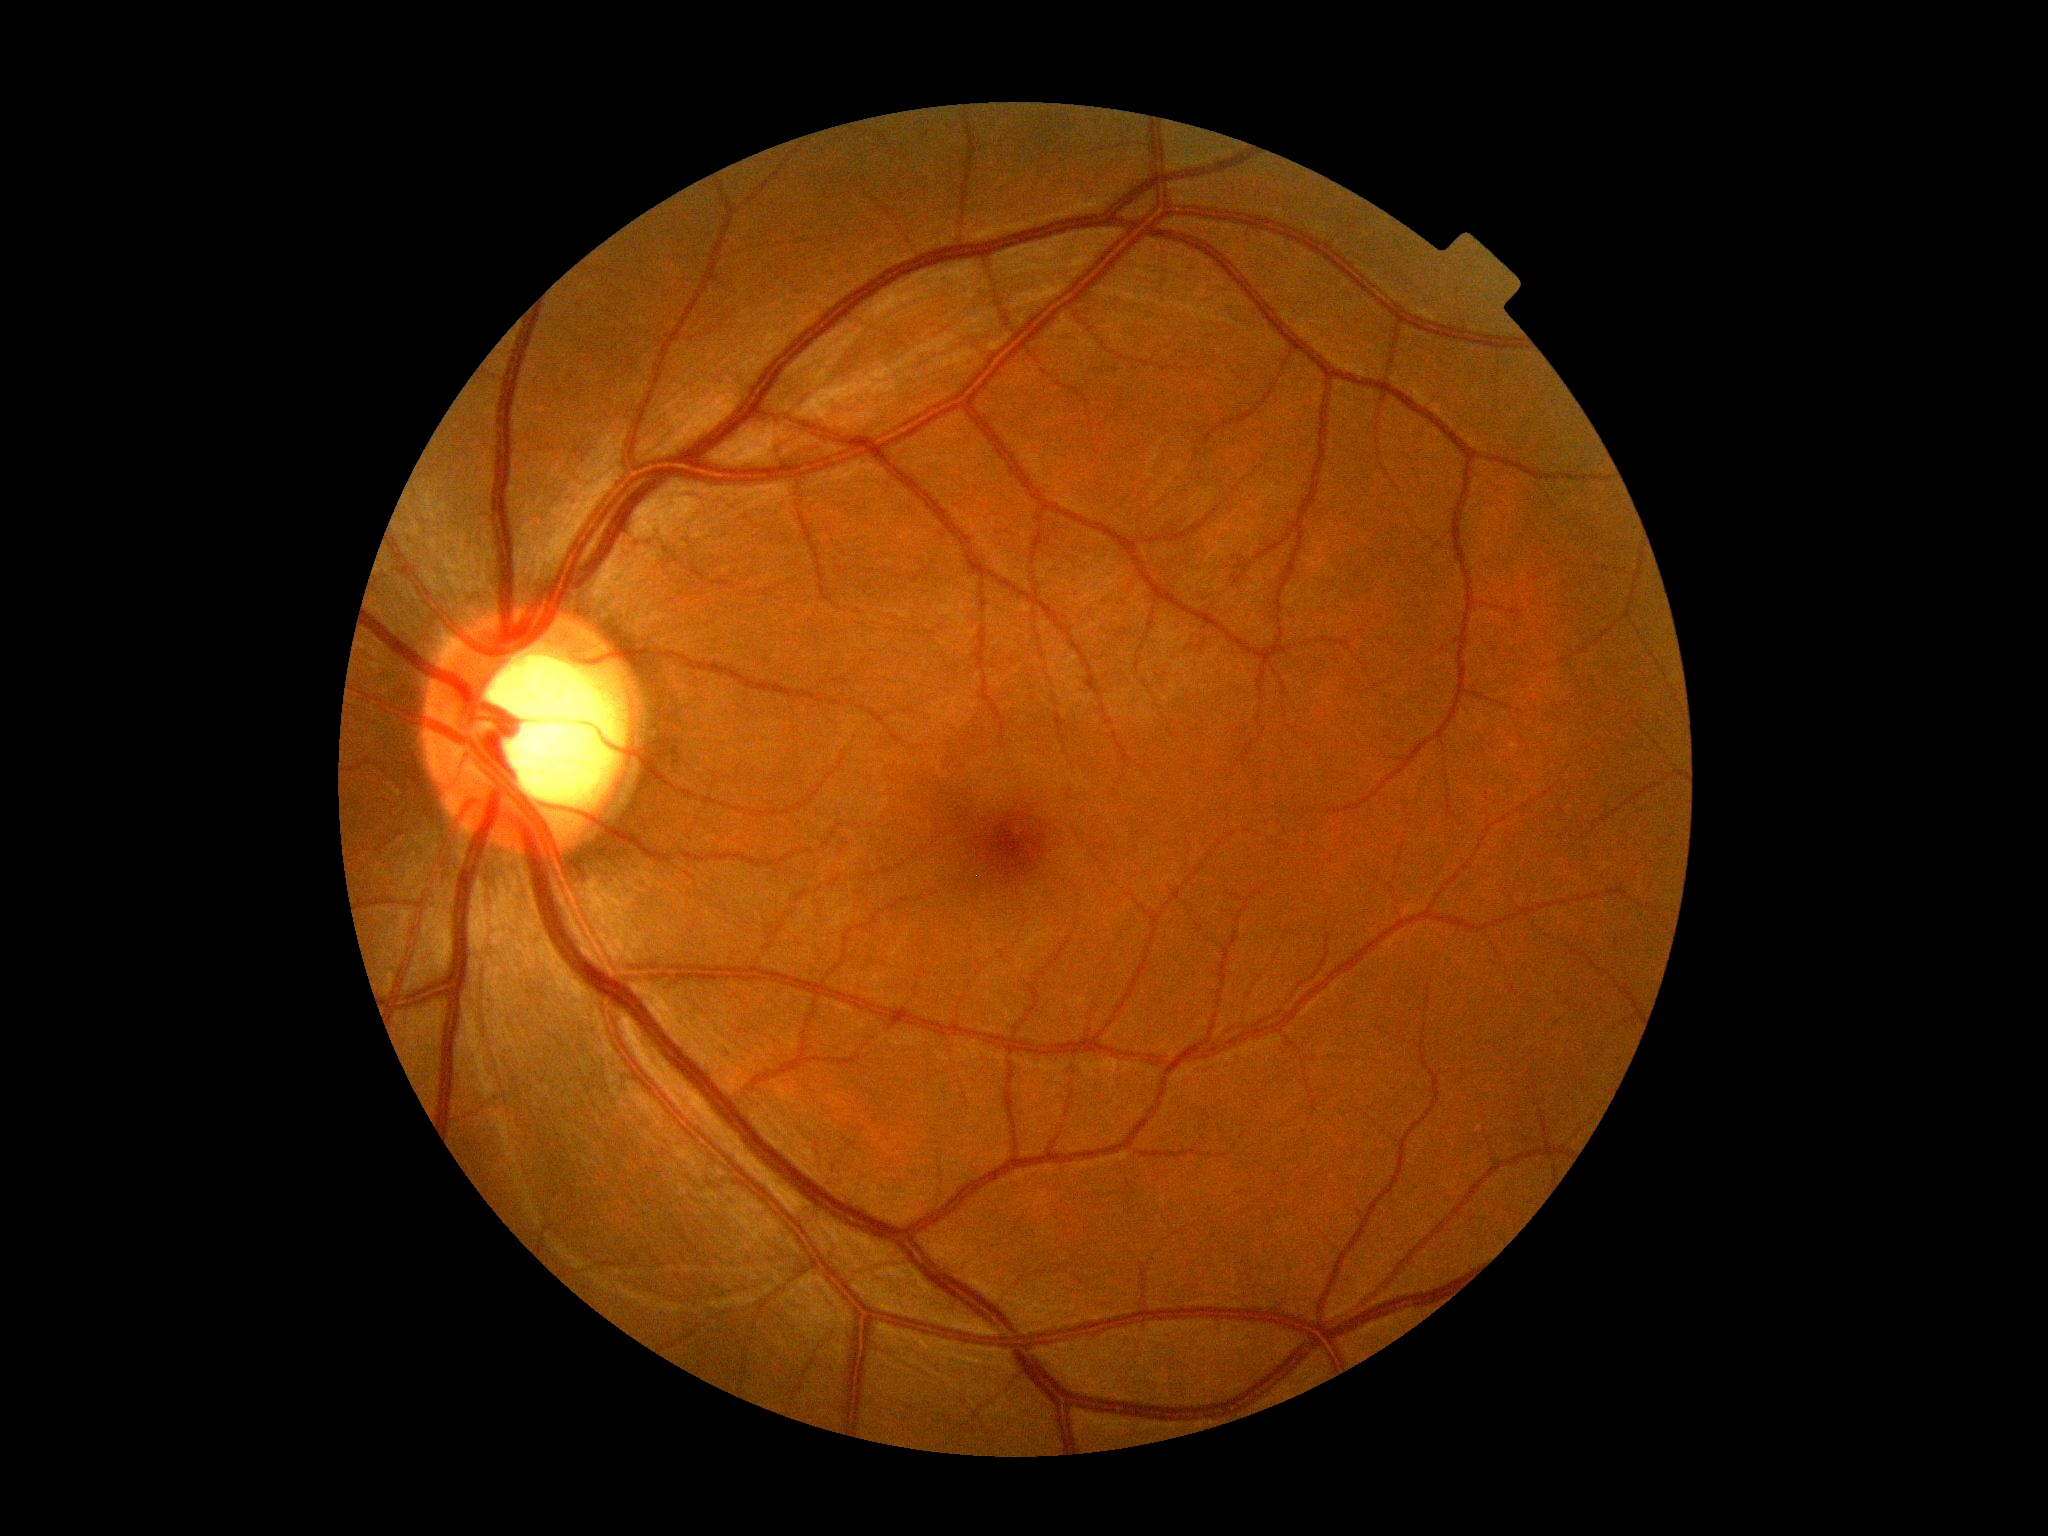

DR grade is 0.